Wide-field fundus photograph of an infant · image size 1240x1240: 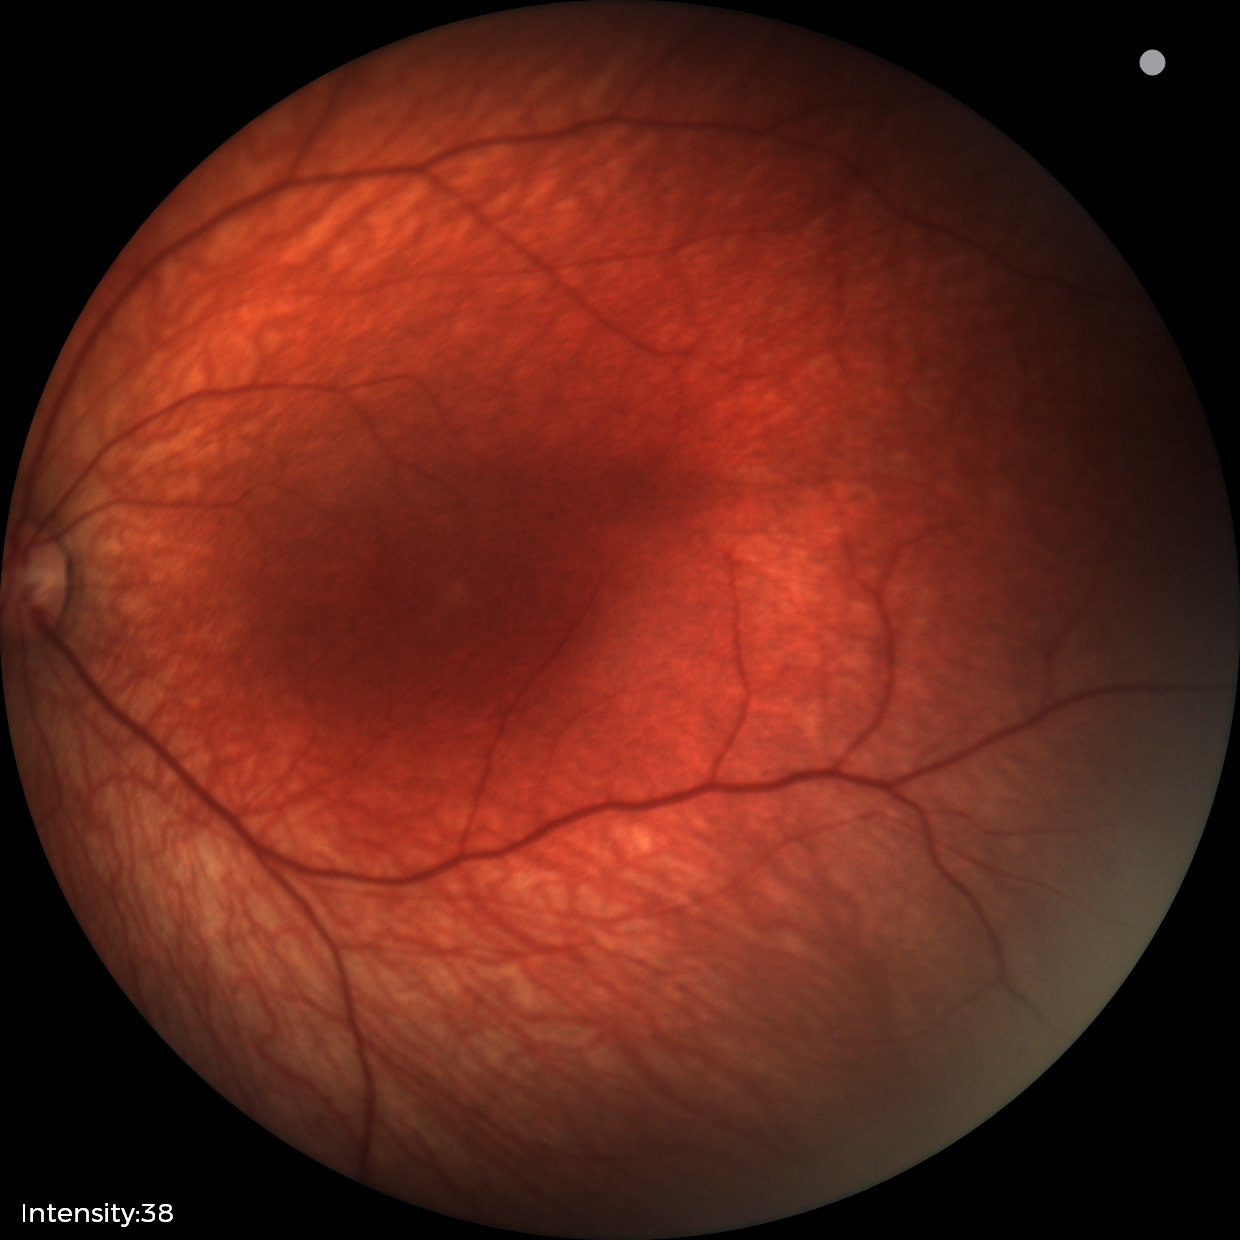
Impression: physiological retinal finding.